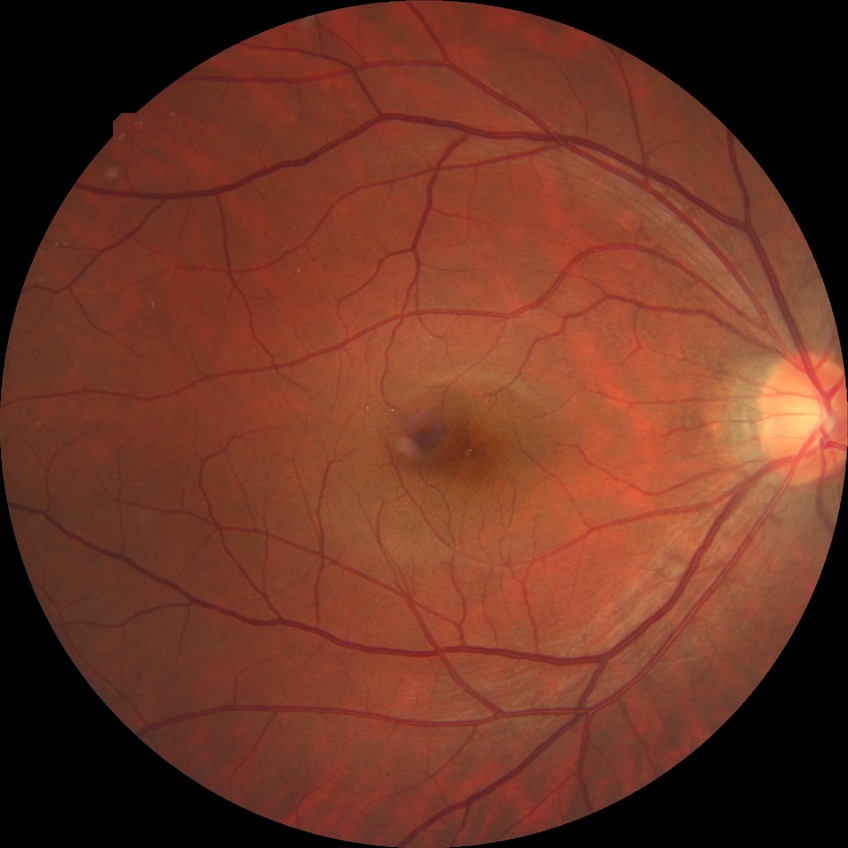

Davis grading is no diabetic retinopathy.